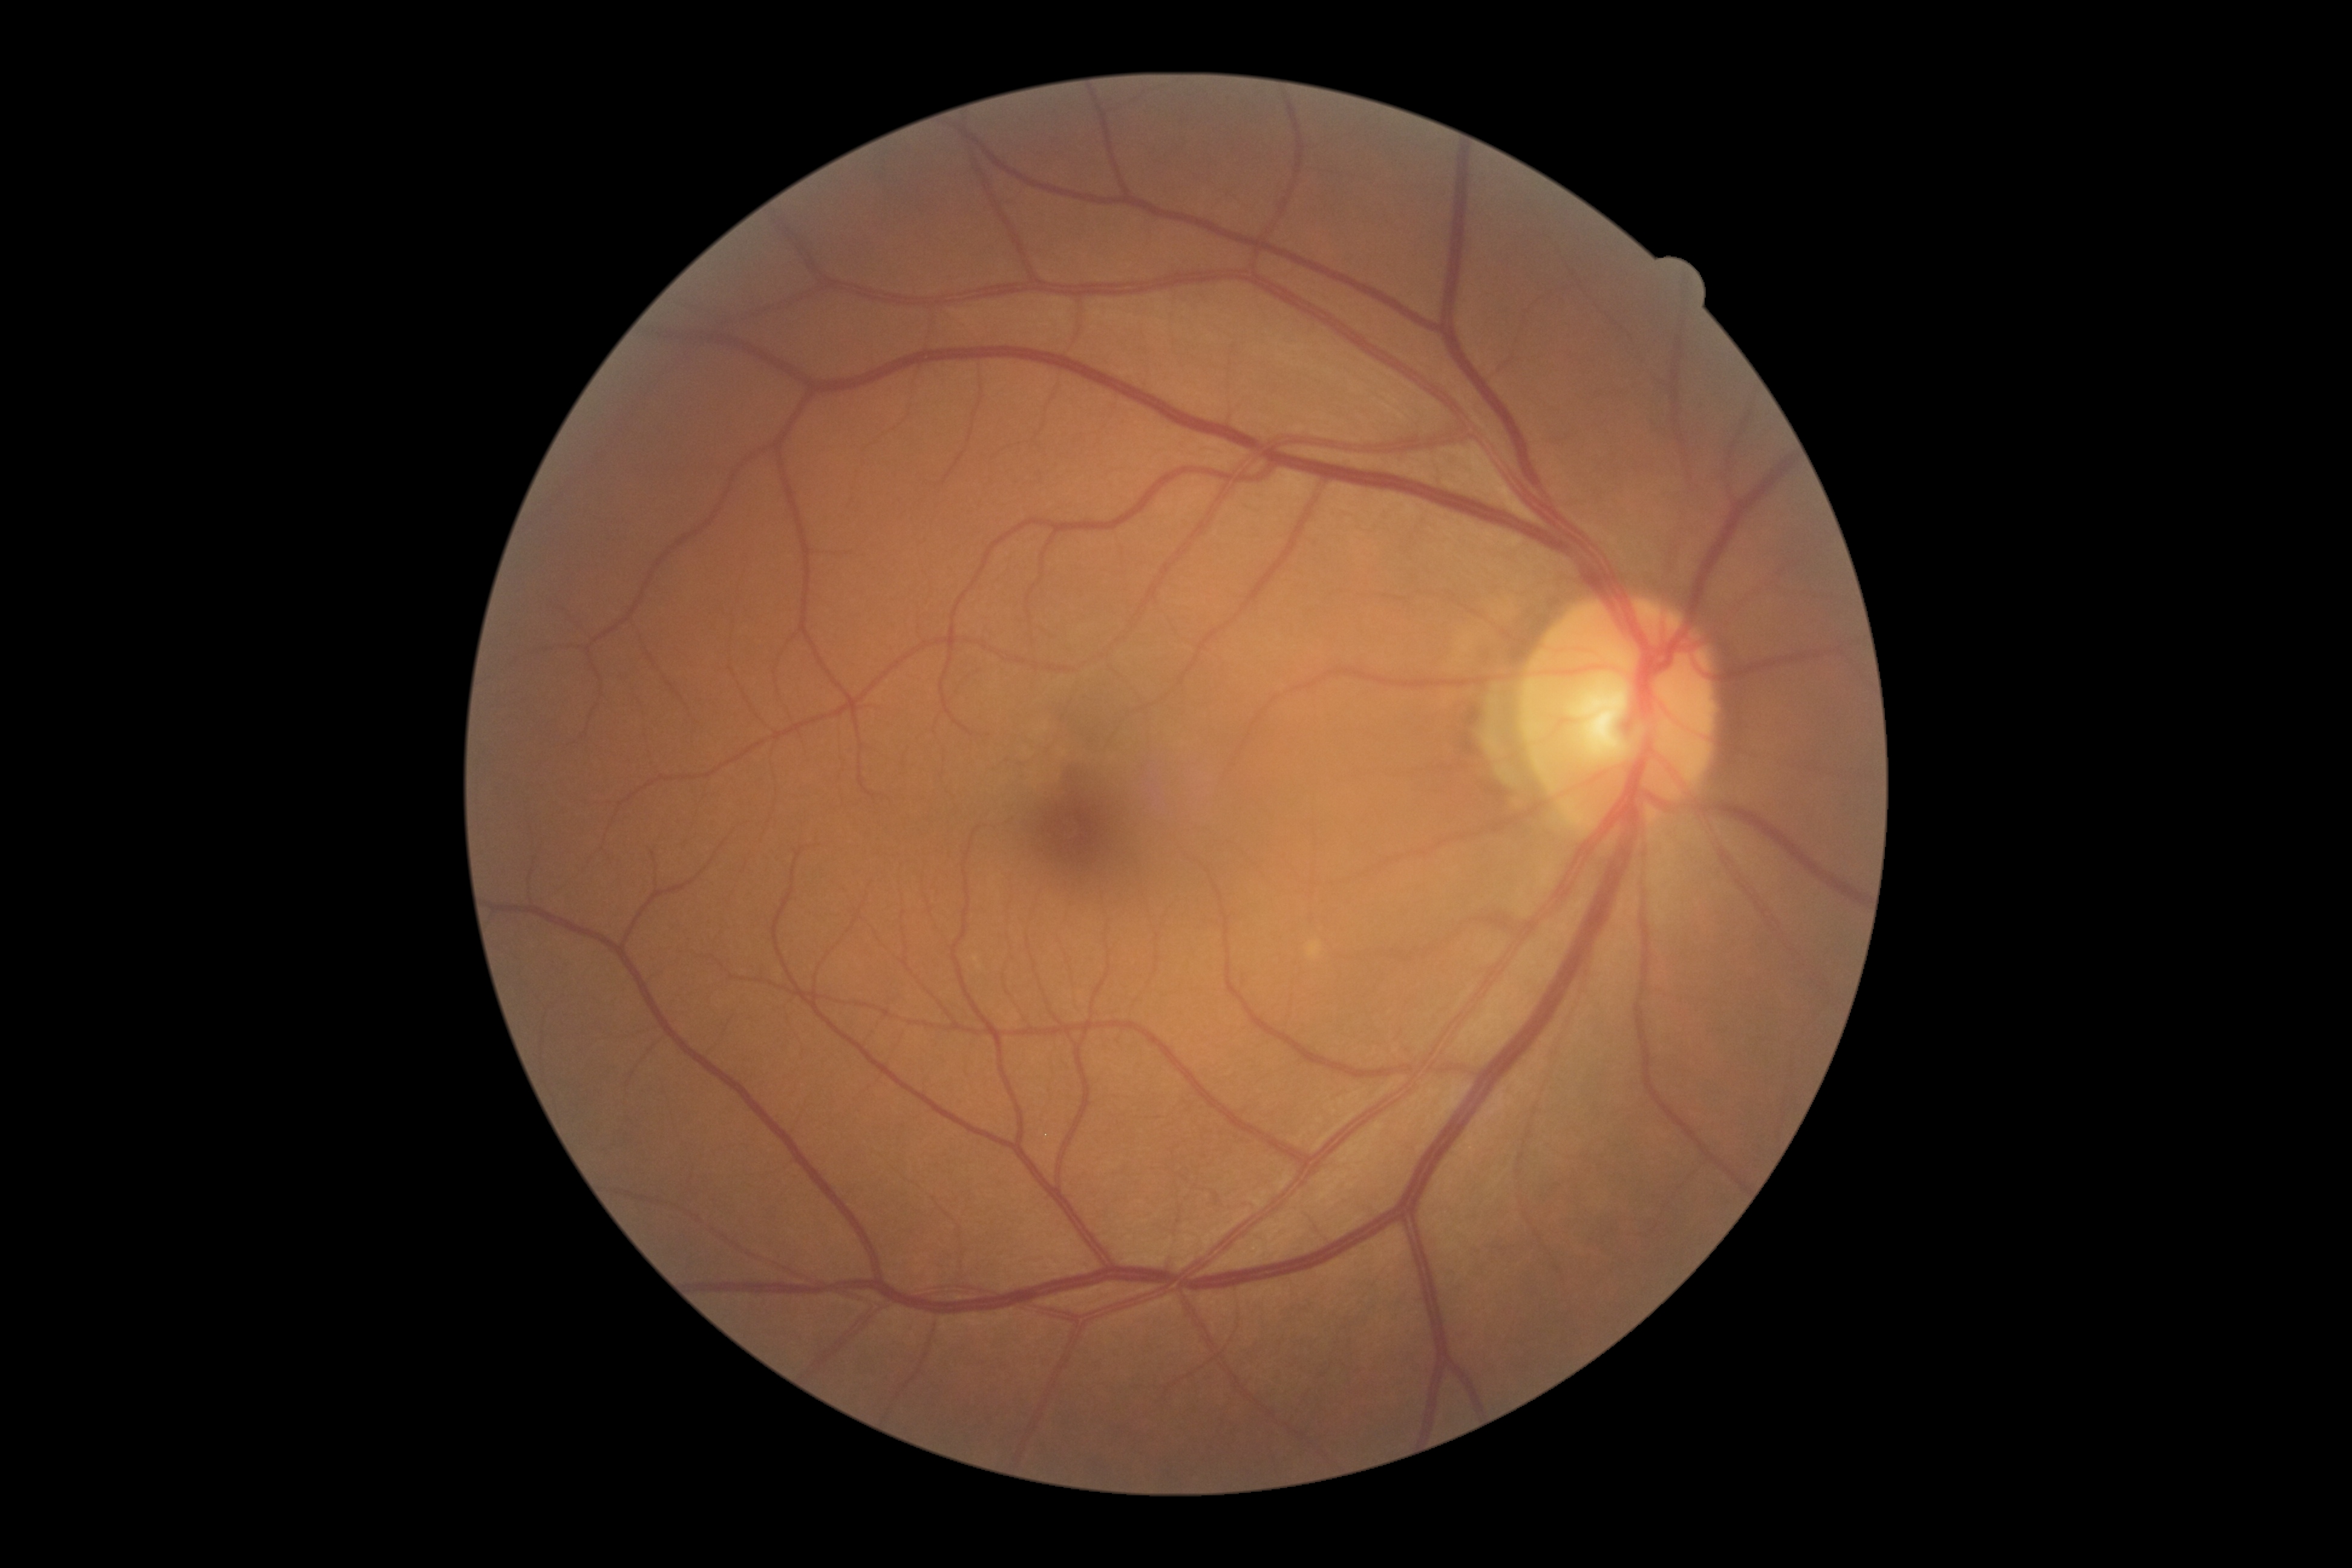

{"dr_impression": "no signs of DR", "dr_grade": "0 — no visible signs of diabetic retinopathy"}